45° field of view.
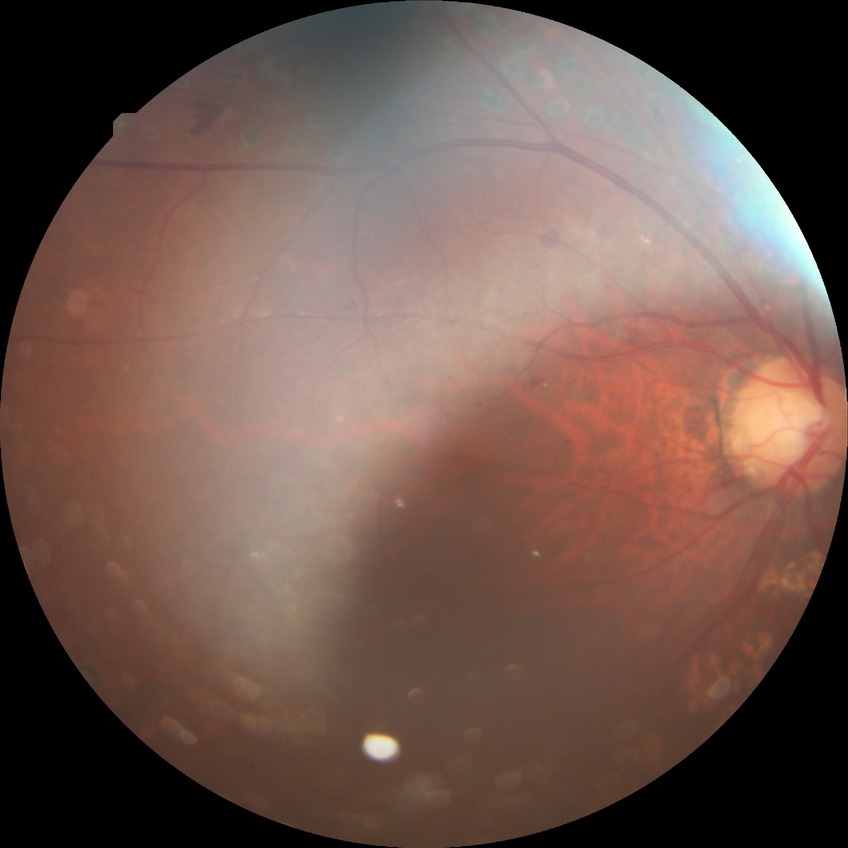 Assessment:
– diabetic retinopathy (DR) — proliferative diabetic retinopathy (PDR)